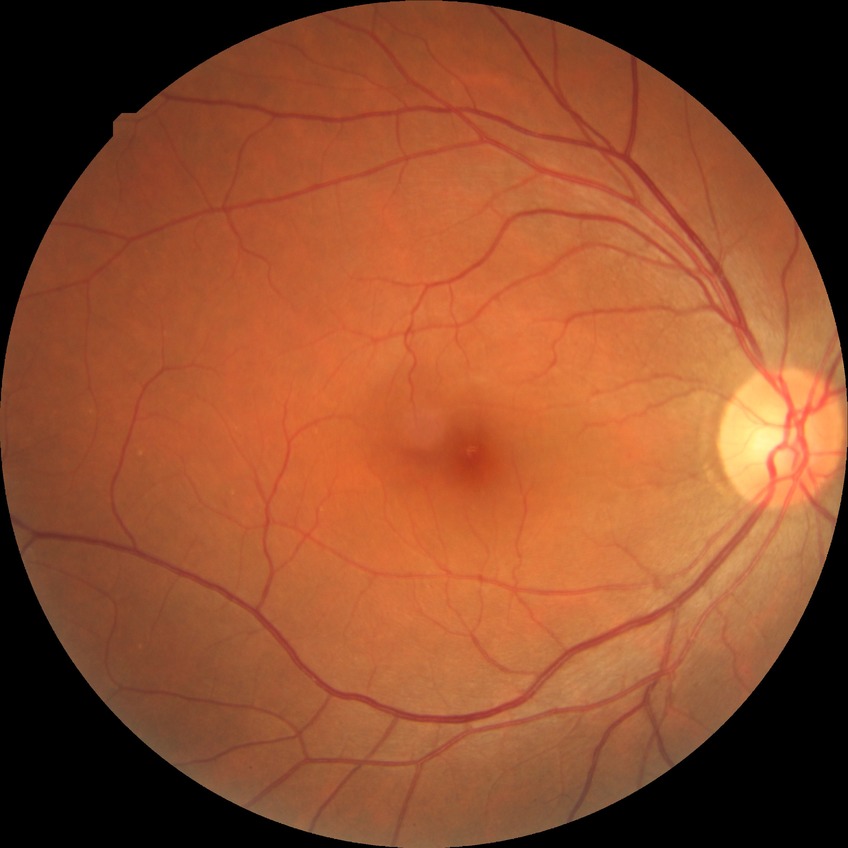
Diabetic retinopathy severity: no diabetic retinopathy.